1932x1910. FOV: 45 degrees. Retinal fundus photograph: 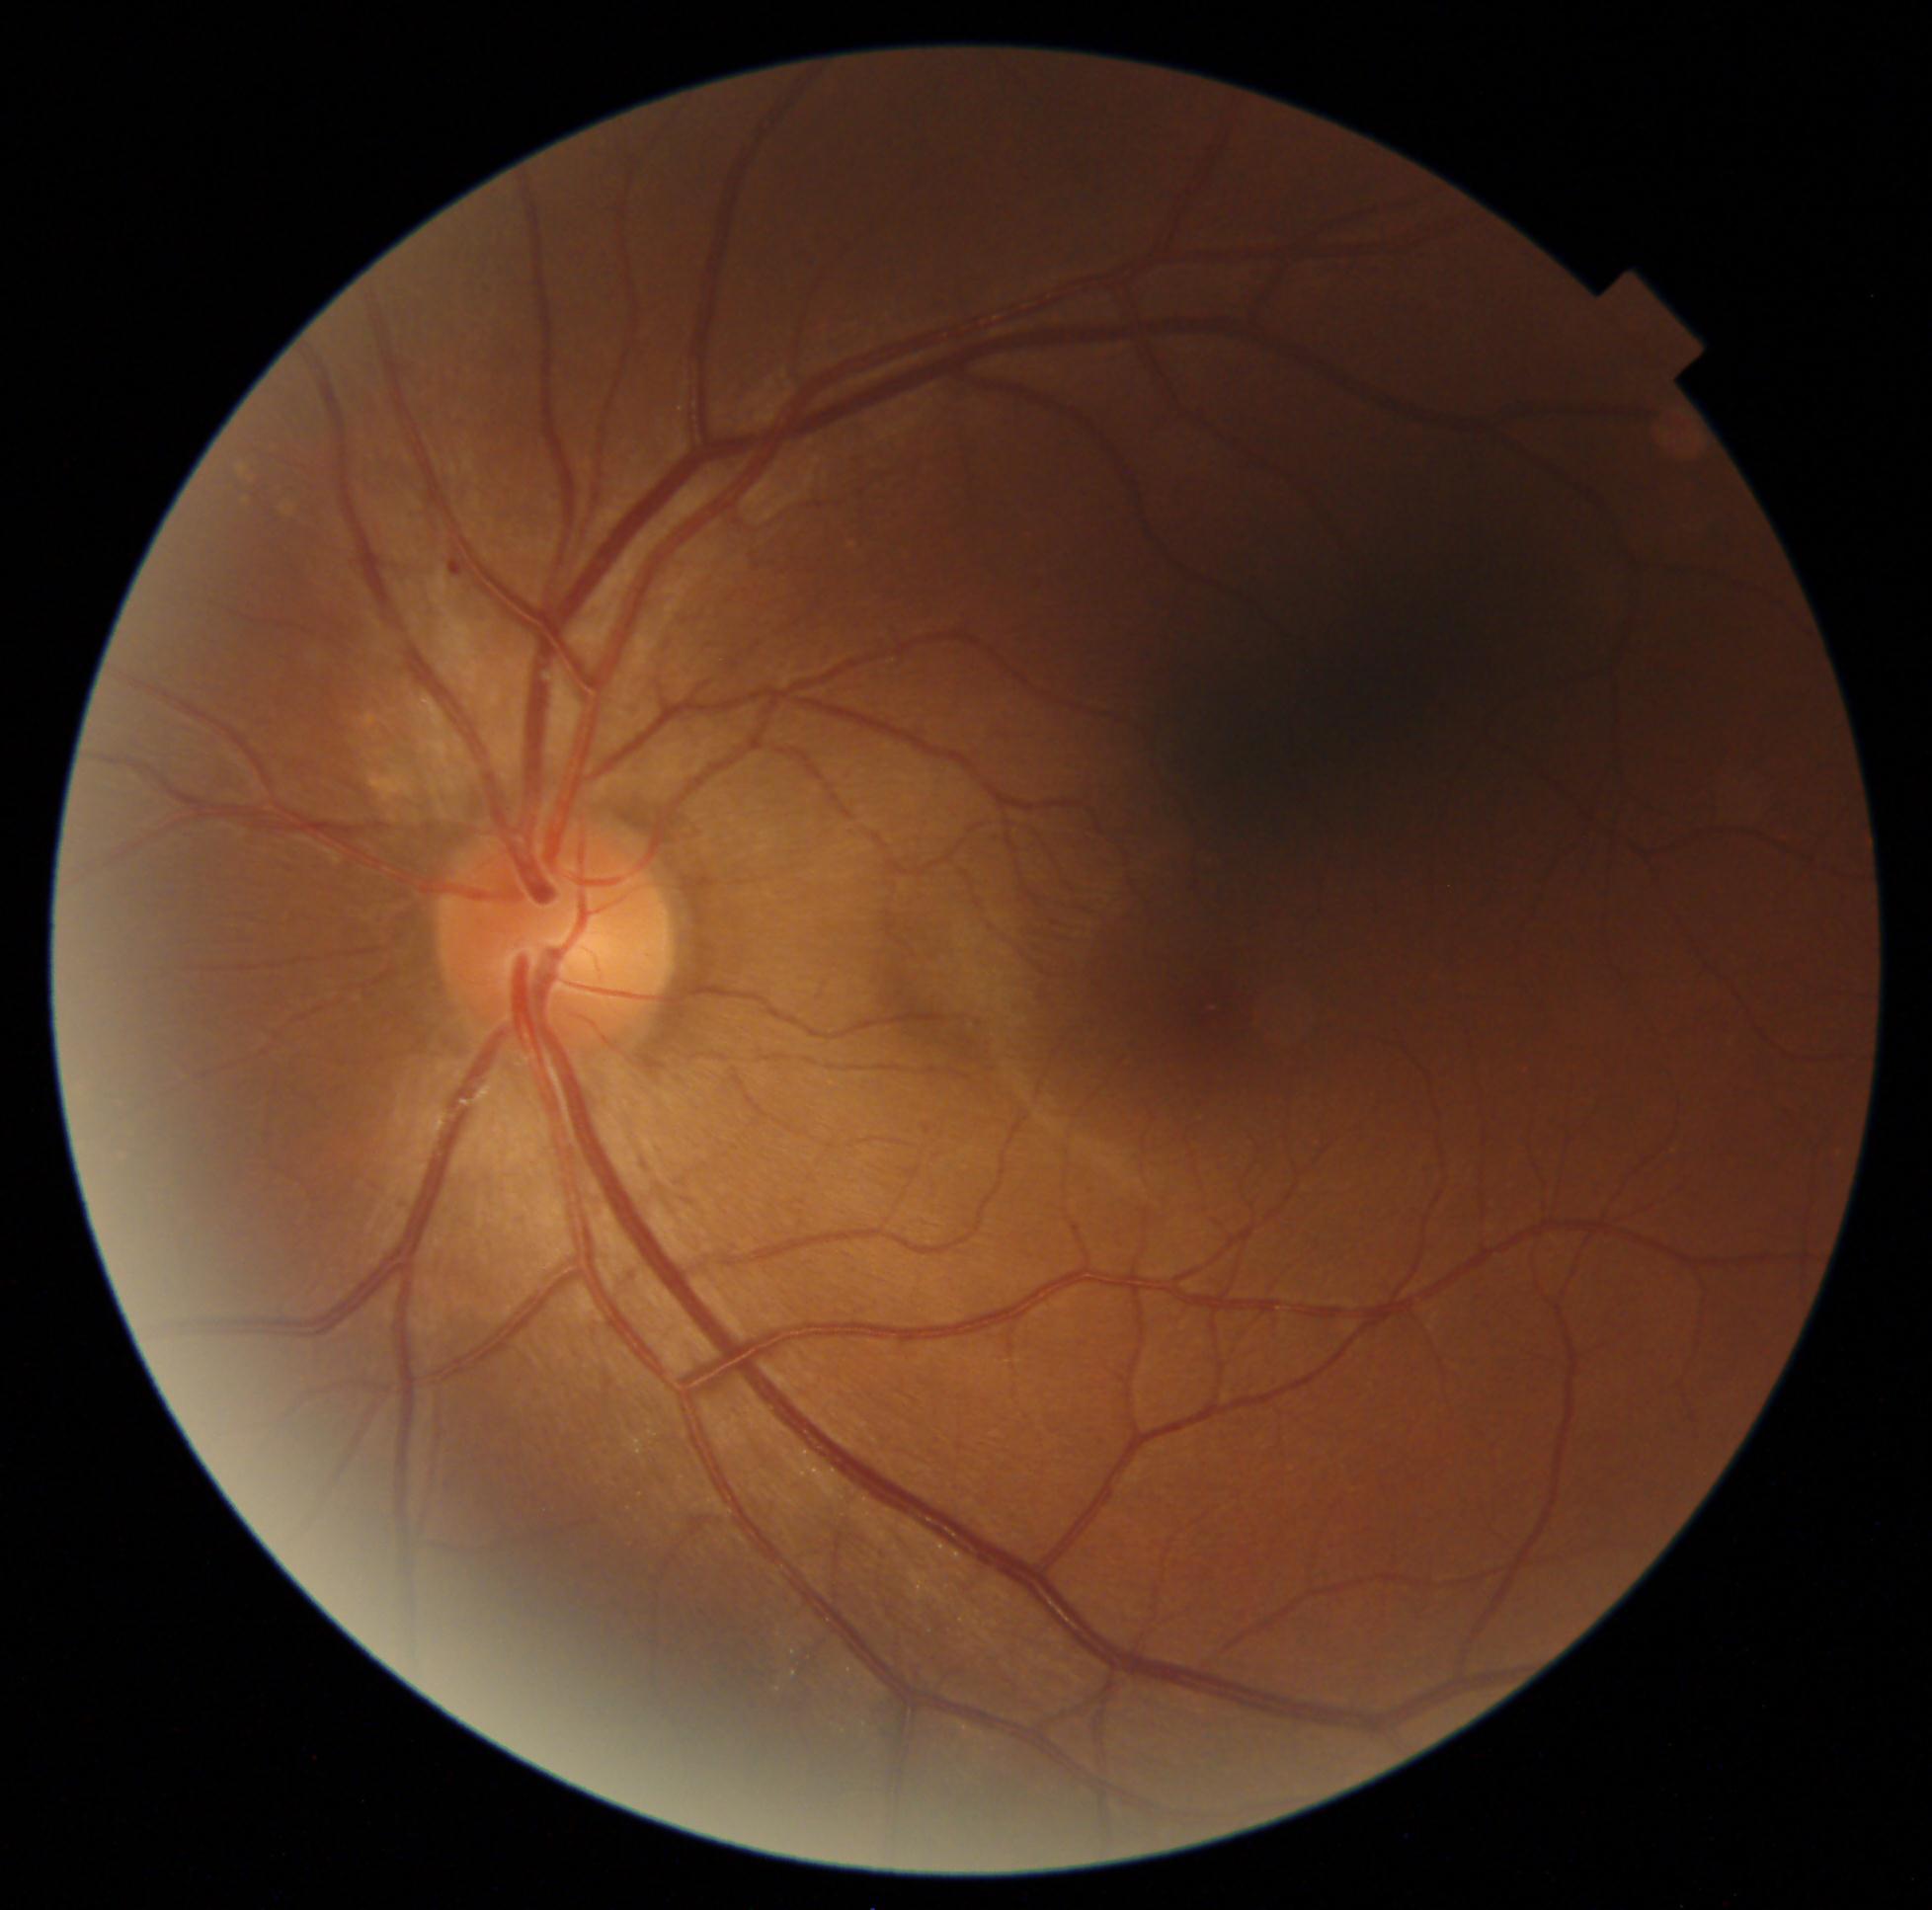 - DR class — non-proliferative diabetic retinopathy
- diabetic retinopathy — grade 1 (mild NPDR)